Fundus photo: 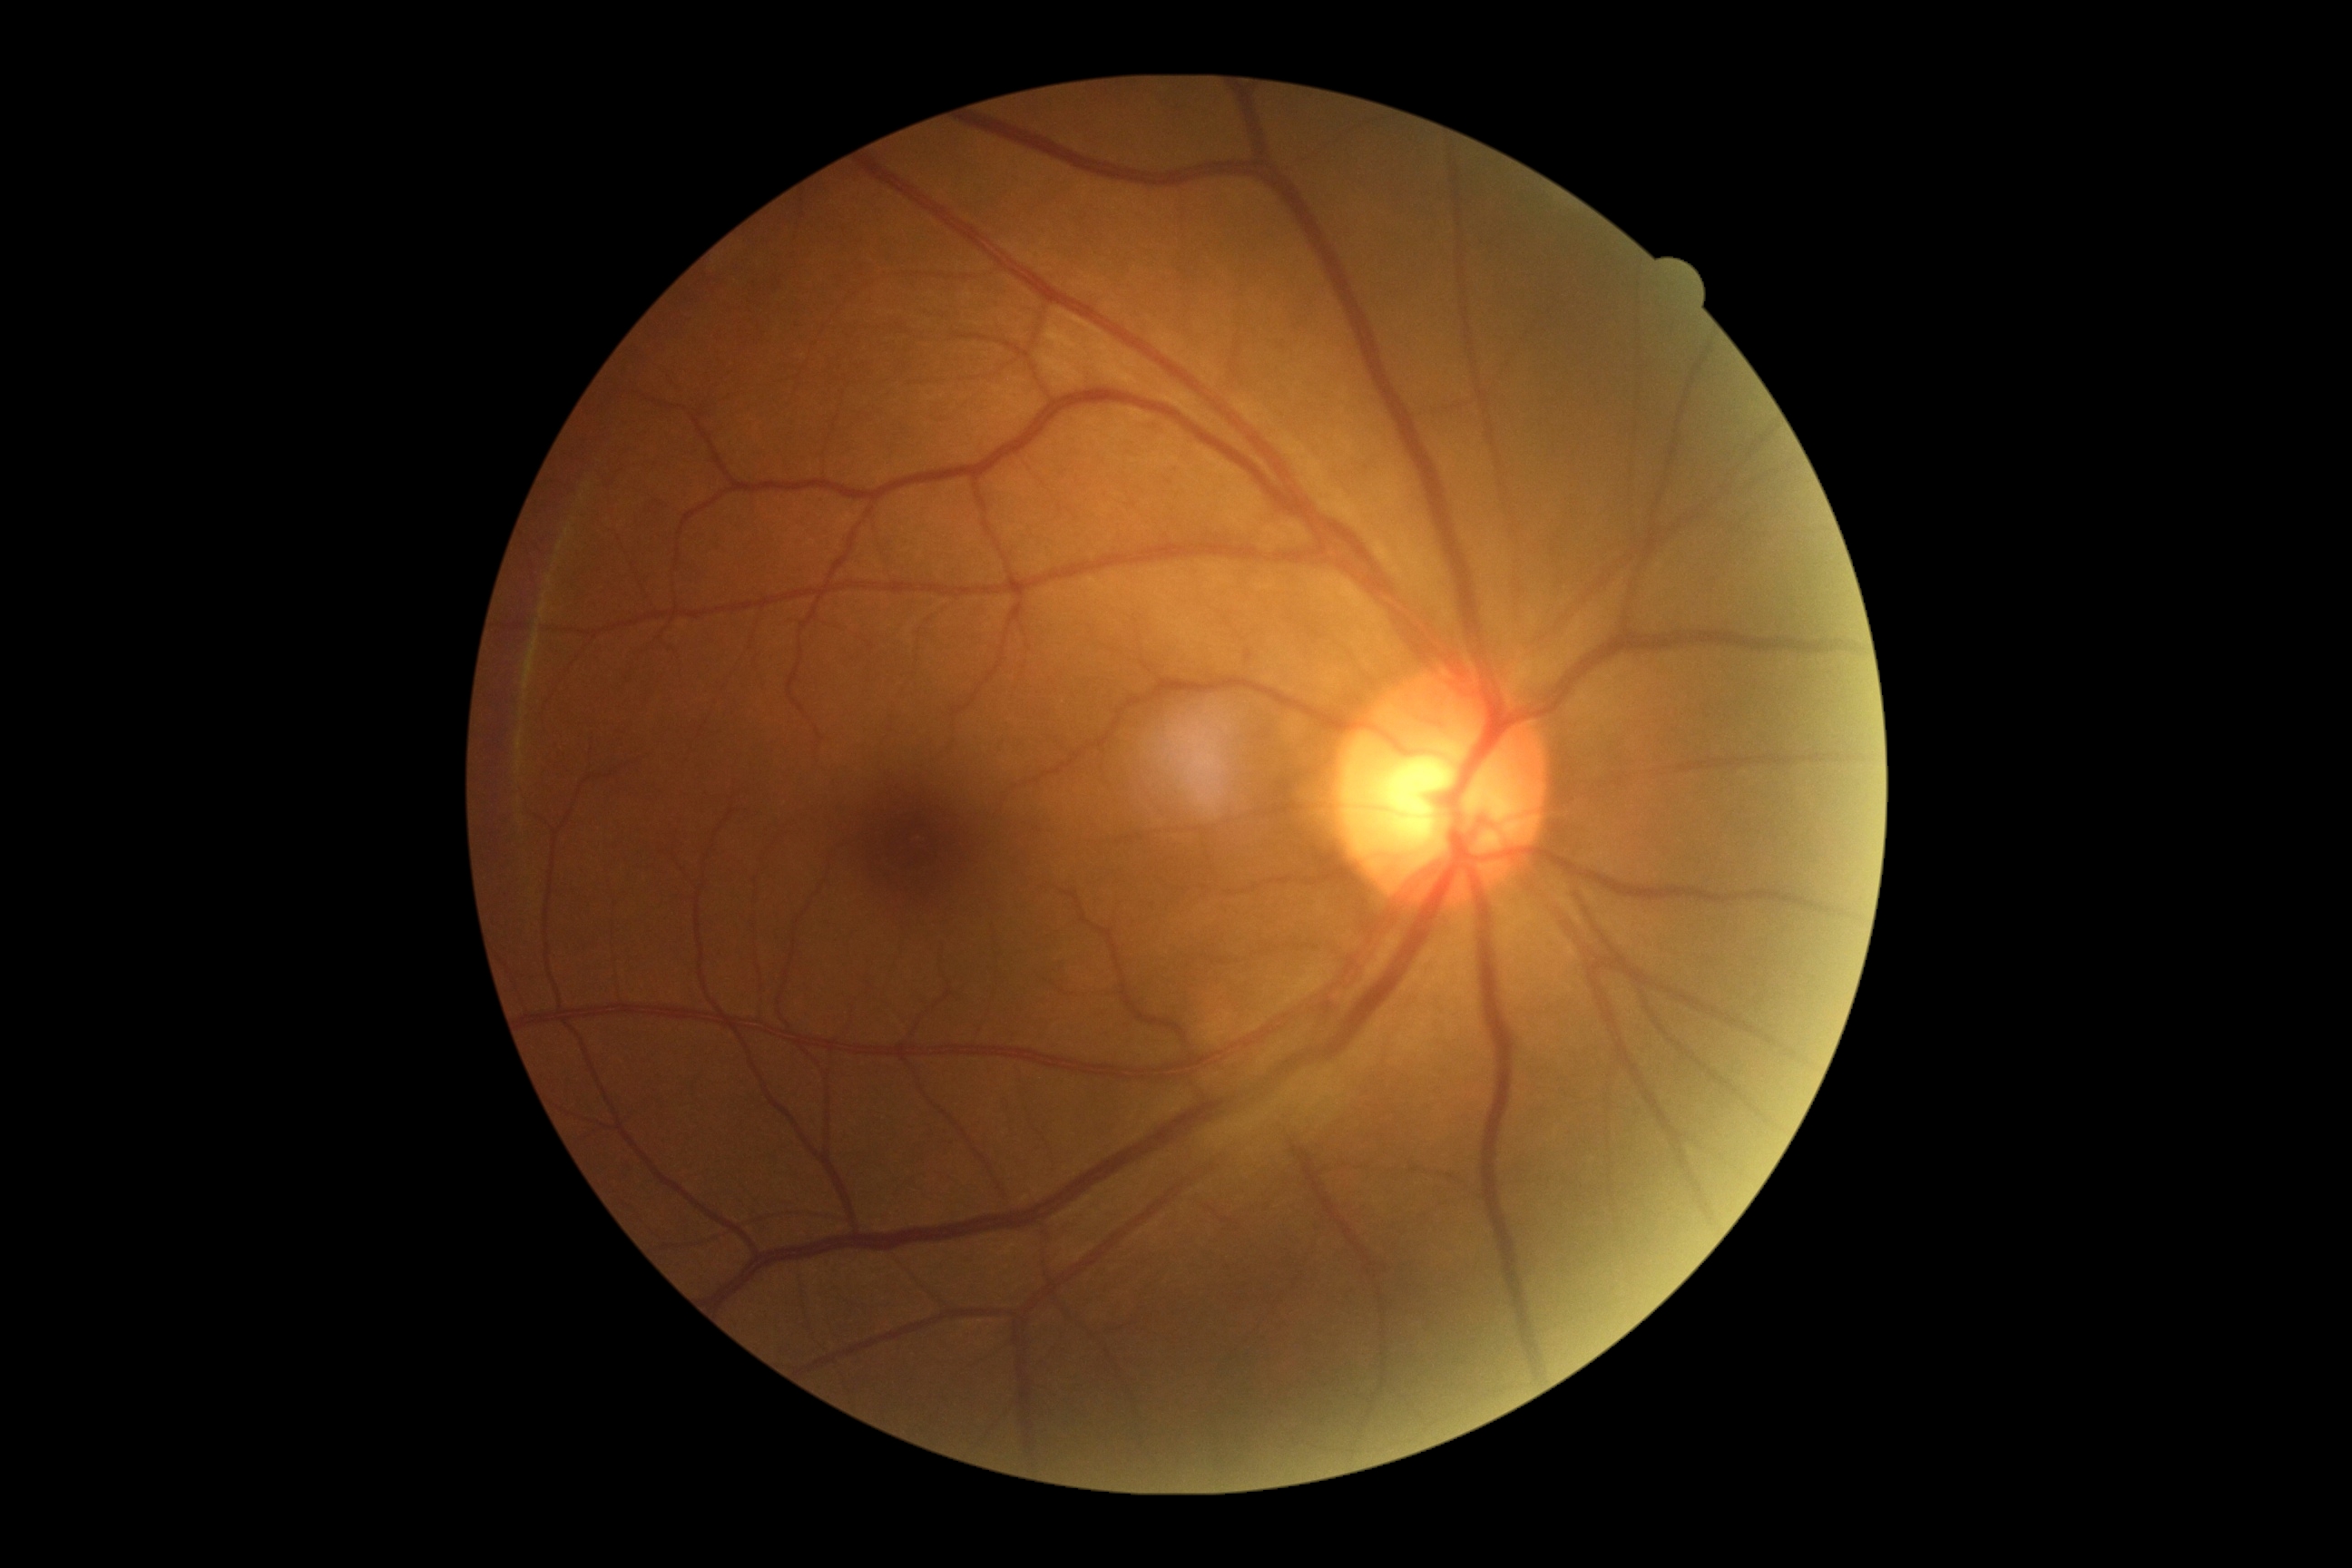

Findings:
– DR impression: negative for DR
– retinopathy: grade 0 (no apparent retinopathy)